Color fundus photograph
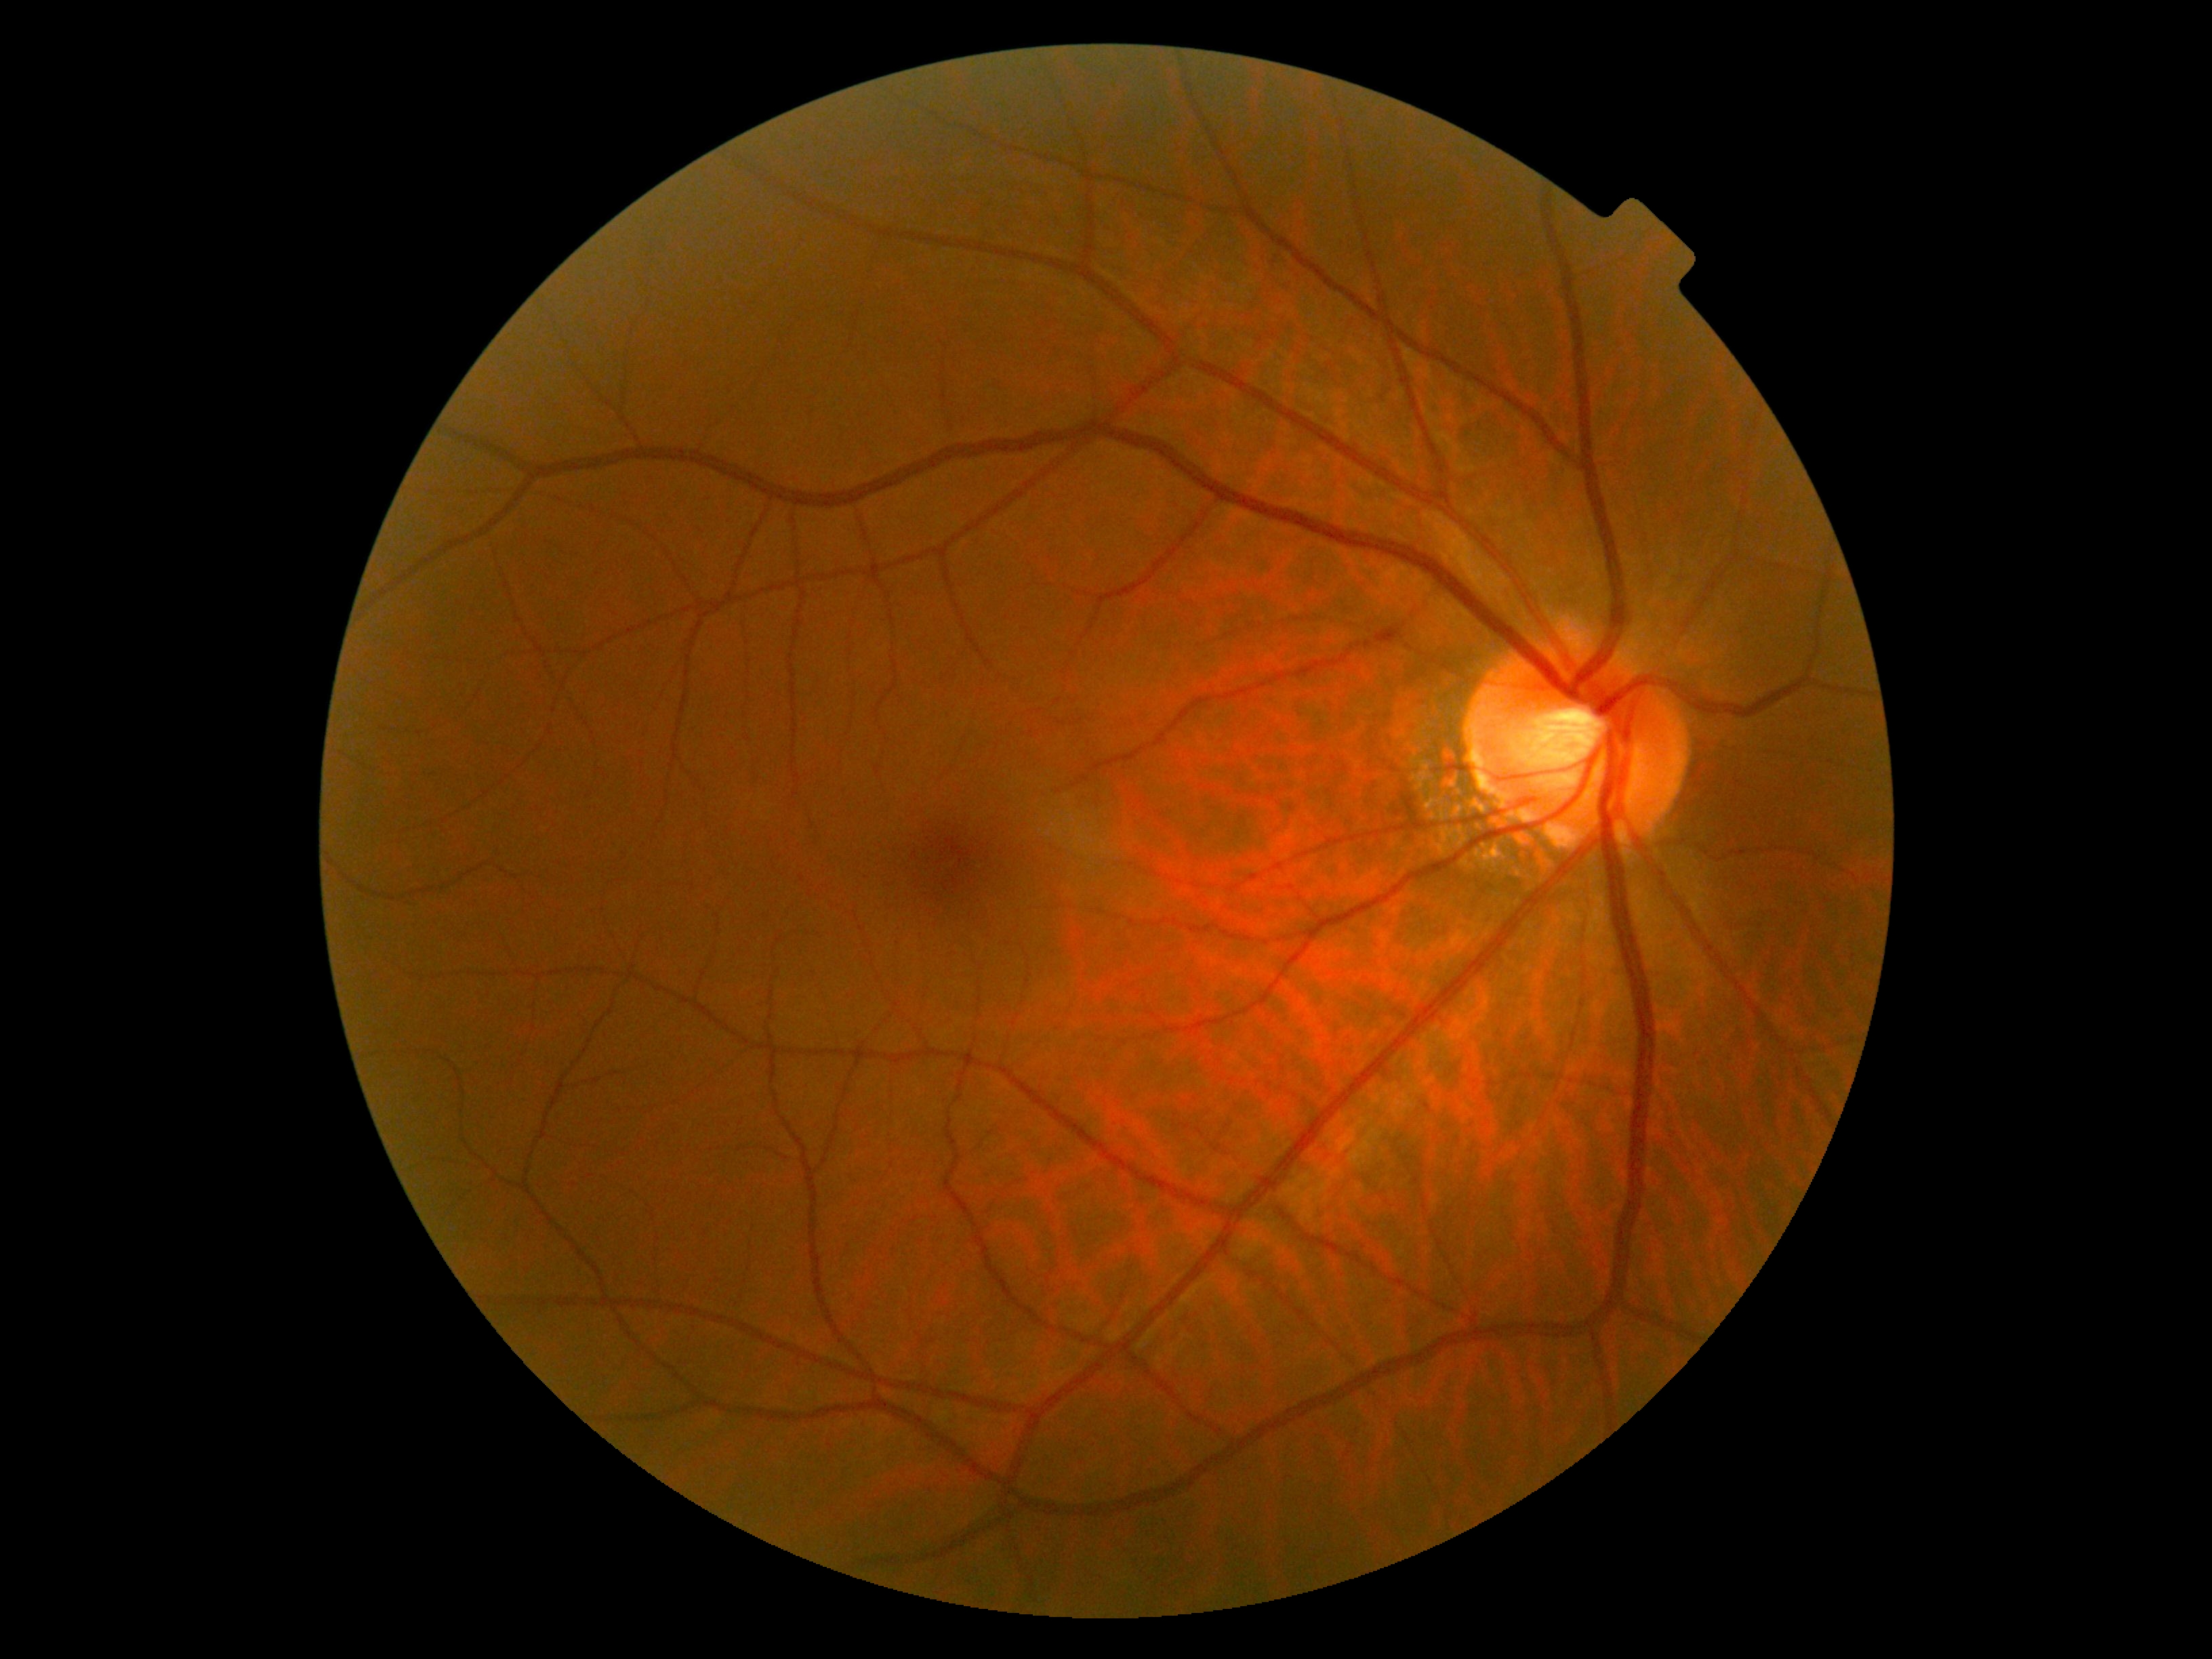 Diabetic retinopathy grade is no apparent diabetic retinopathy (0) — no visible signs of diabetic retinopathy. No diabetic retinal disease findings.